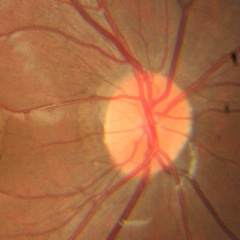 Optic disc photograph demonstrating no glaucomatous changes.